Nonmydriatic fundus photograph, posterior pole photograph, 848 x 848 pixels, 45° FOV
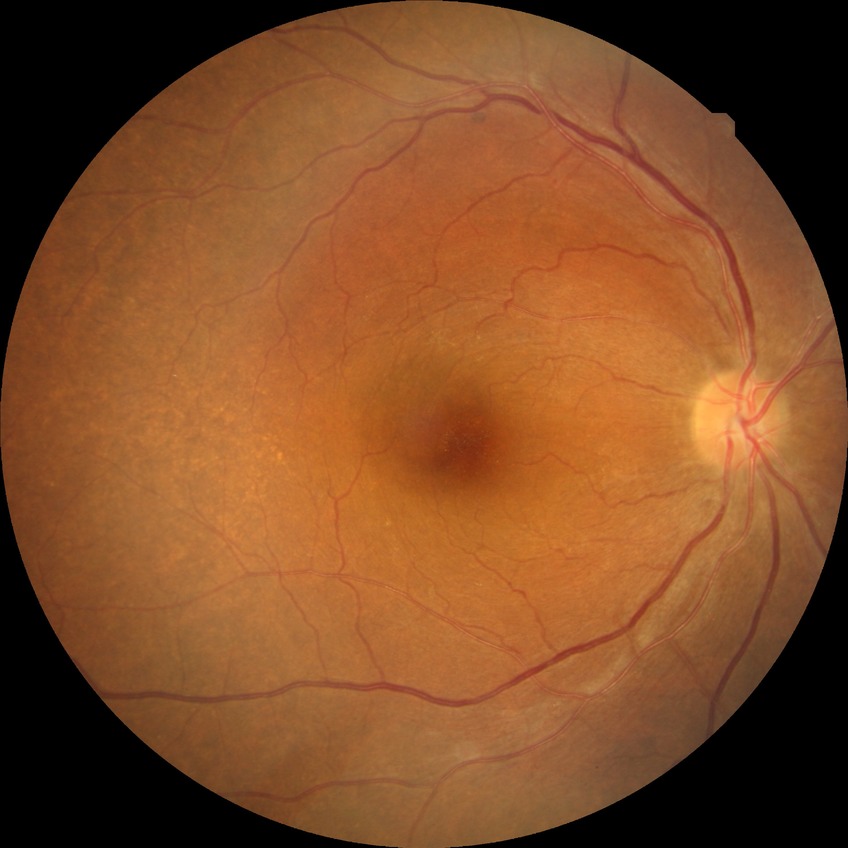 retinopathy grade@no diabetic retinopathy.